848 by 848 pixels, posterior pole color fundus photograph, diabetic retinopathy graded by the modified Davis classification, acquired with a NIDEK AFC-230:
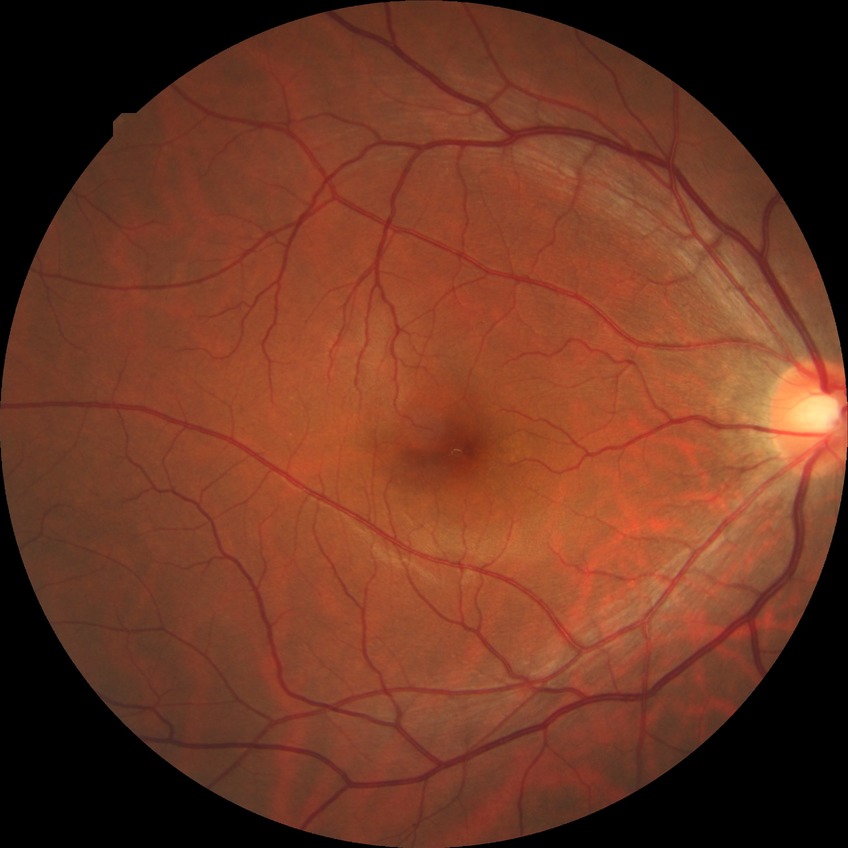
Modified Davis classification: no diabetic retinopathy.